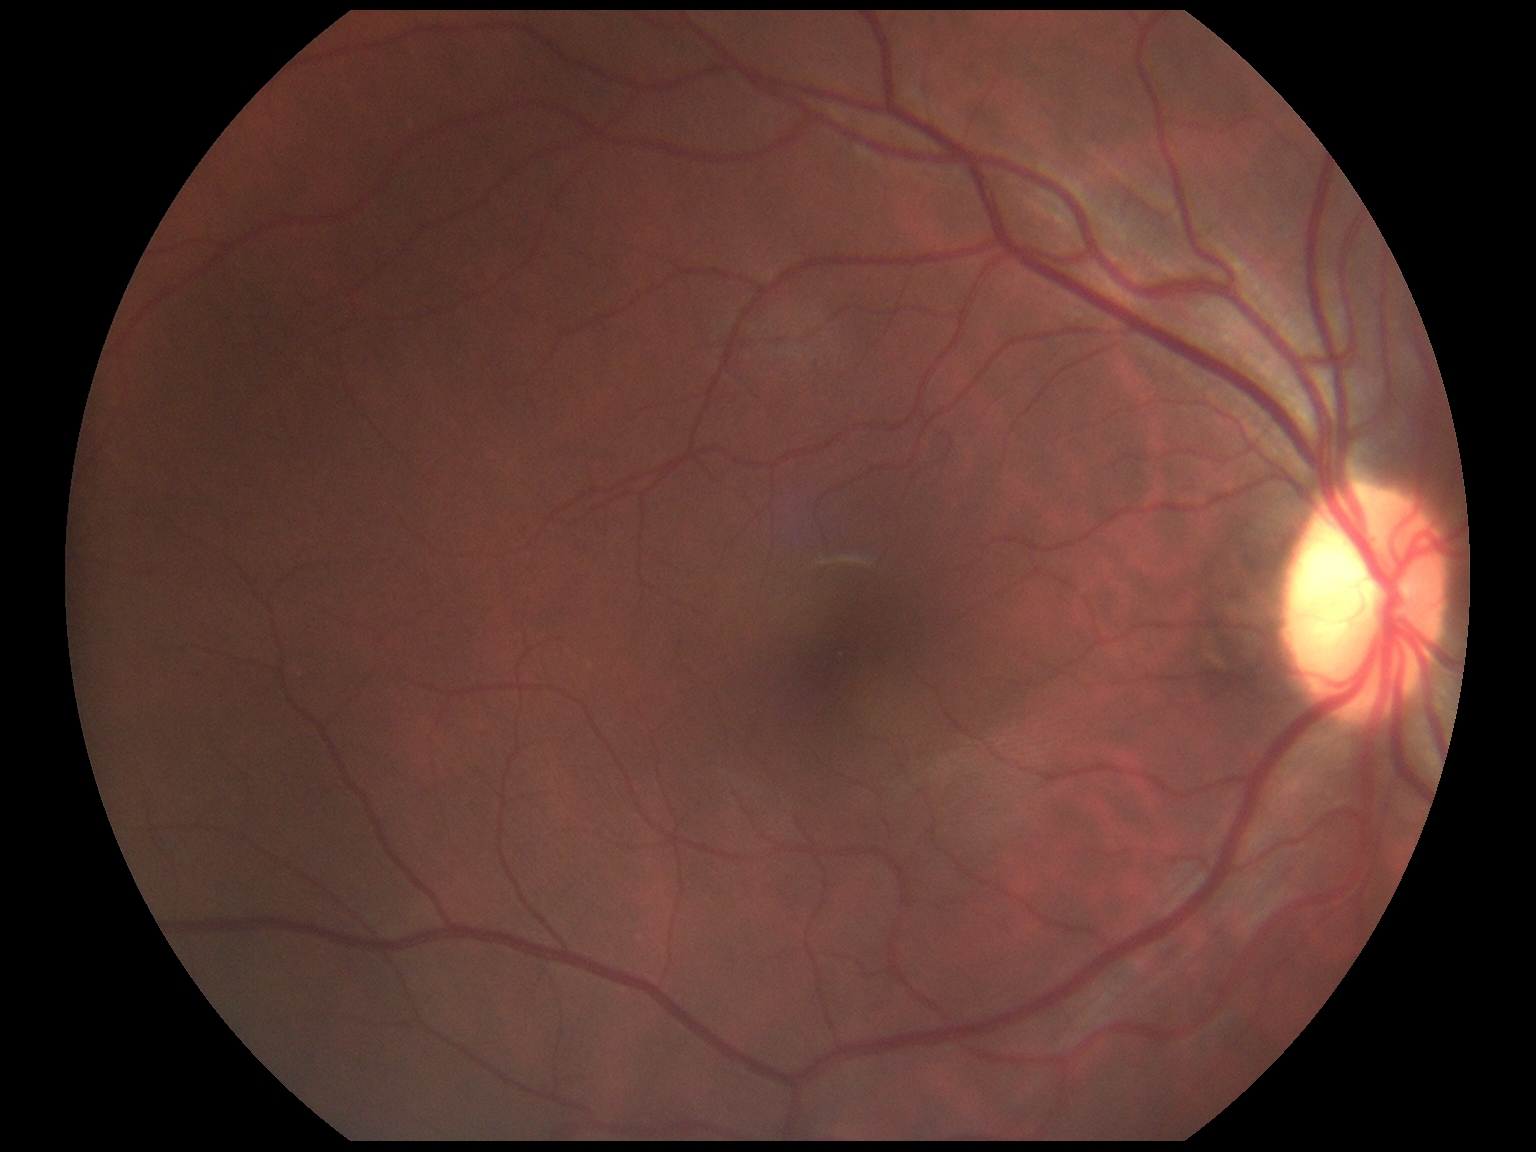 DR stage is grade 0 (no apparent retinopathy).